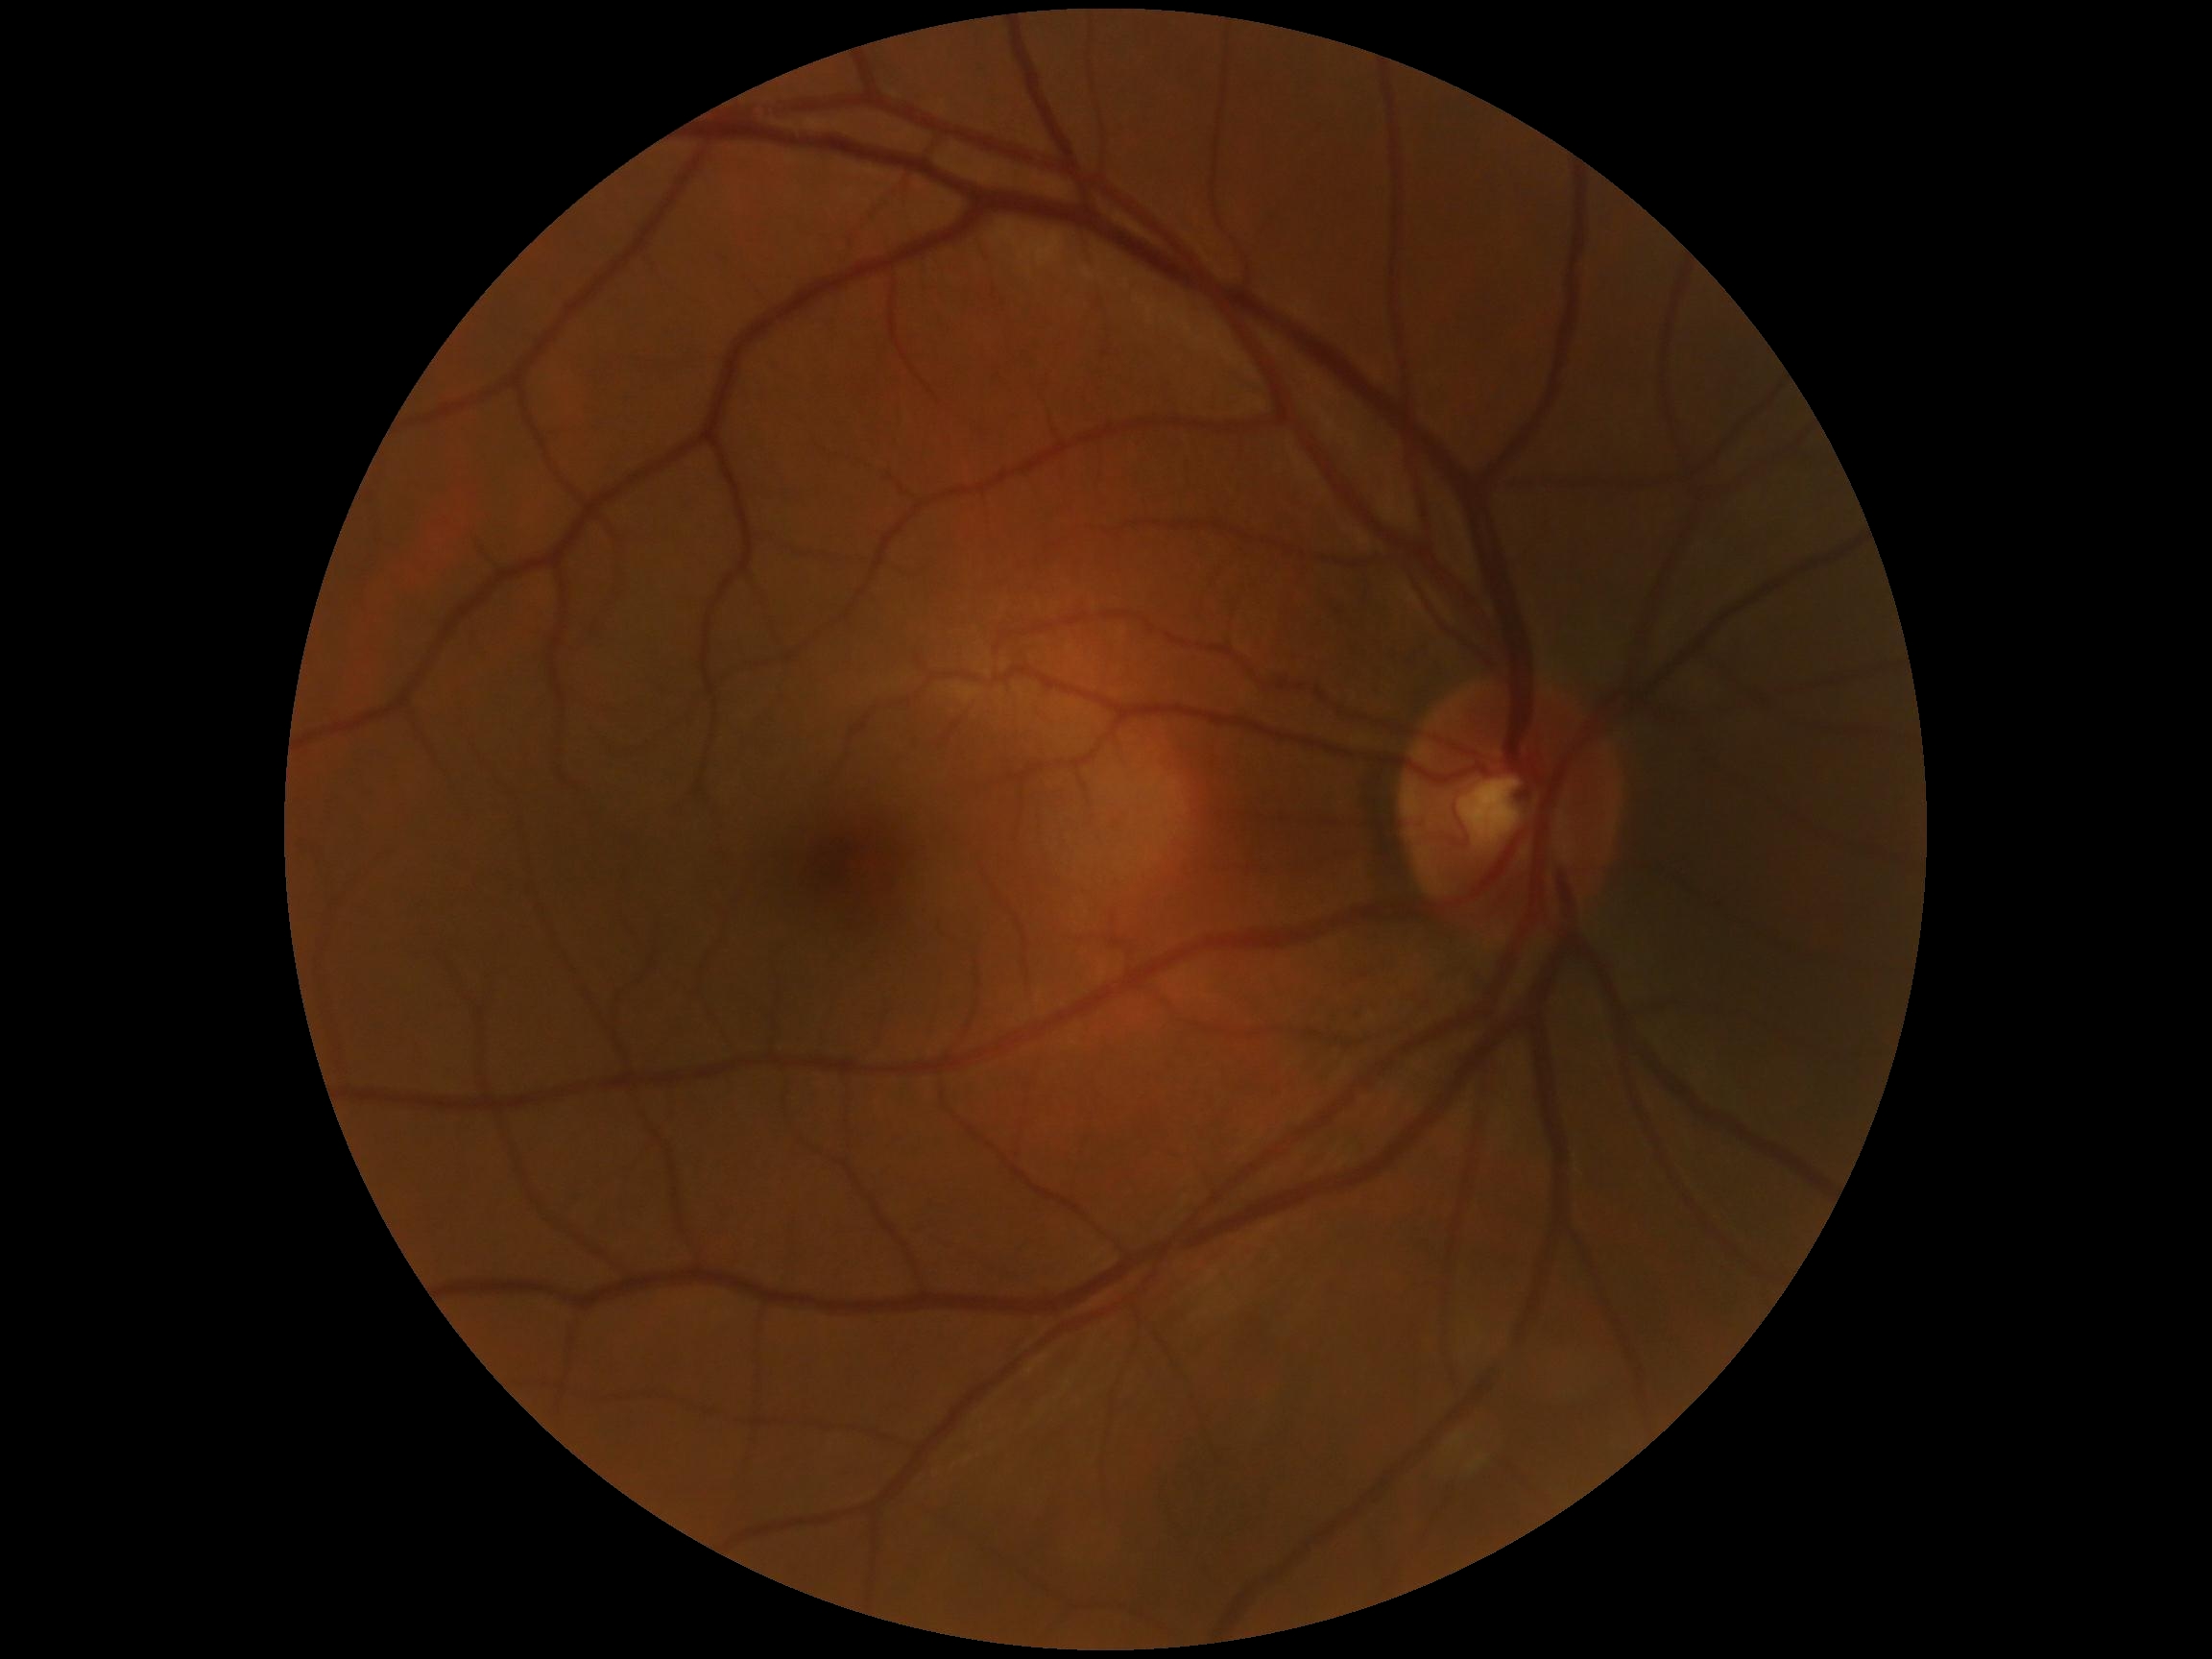 DR is grade 0.